45-degree field of view:
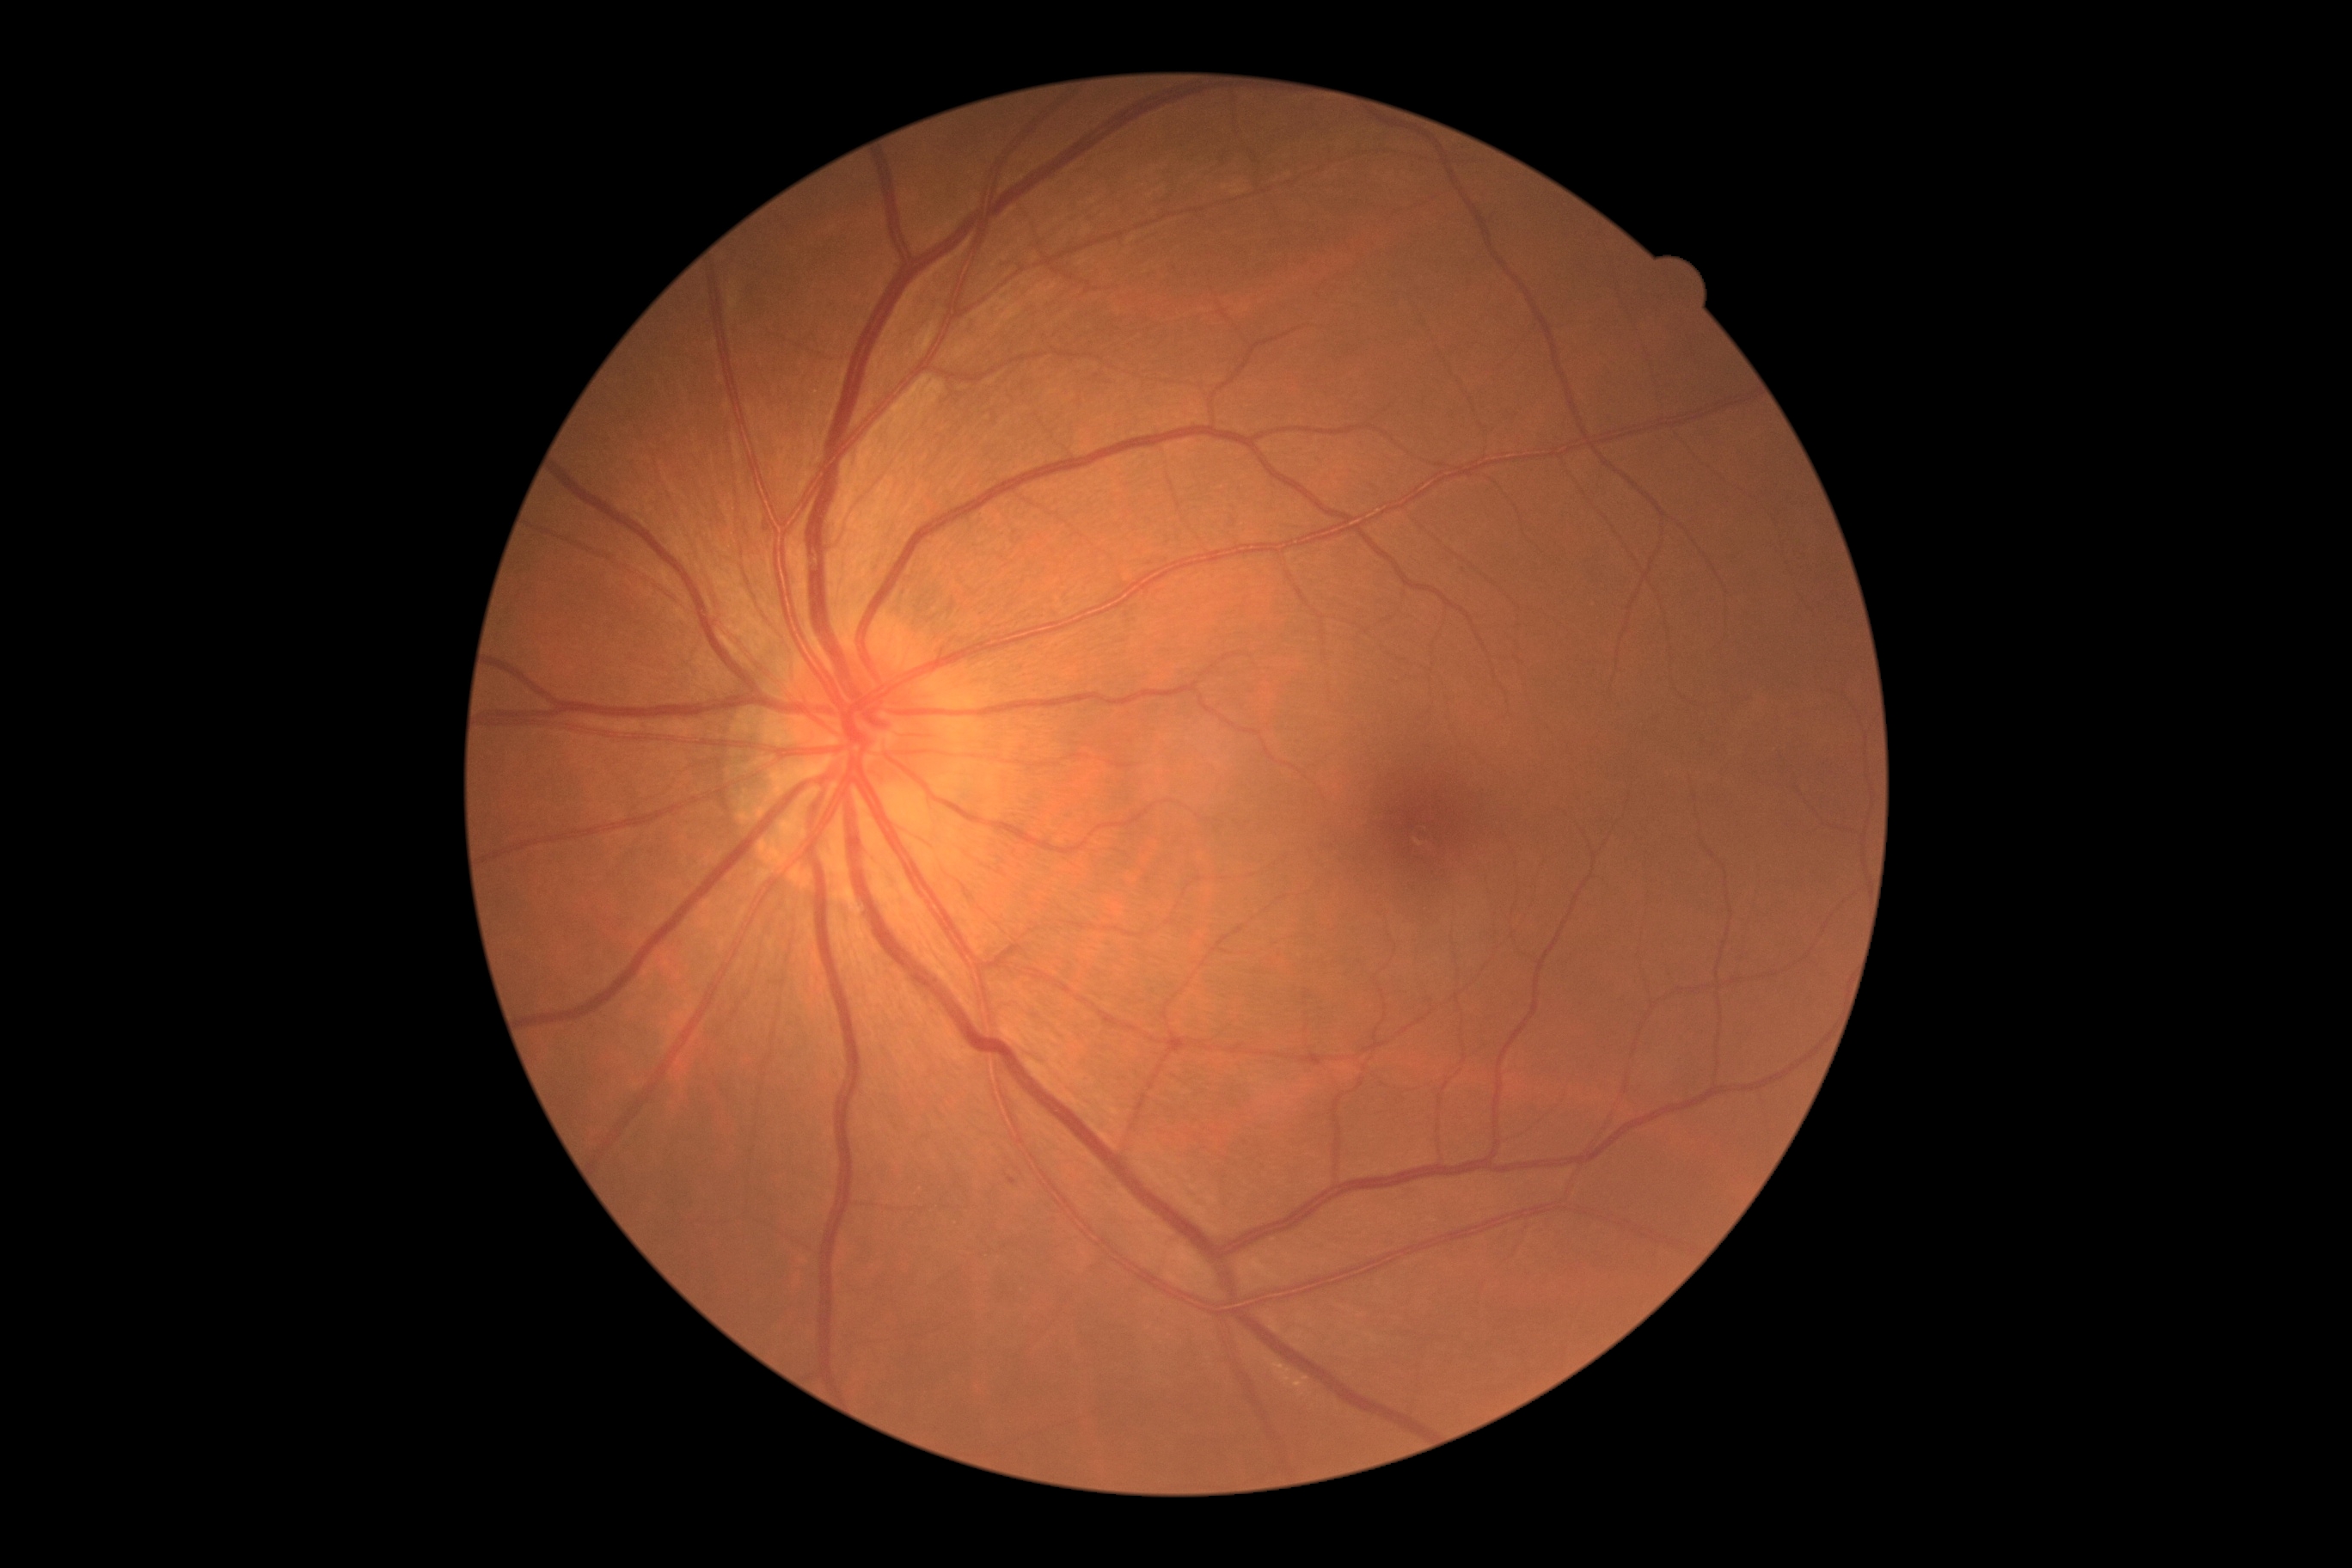 DR severity: mild NPDR (grade 1).